1240 x 1240 pixels · wide-field fundus photograph of an infant · Phoenix ICON, 100° FOV.
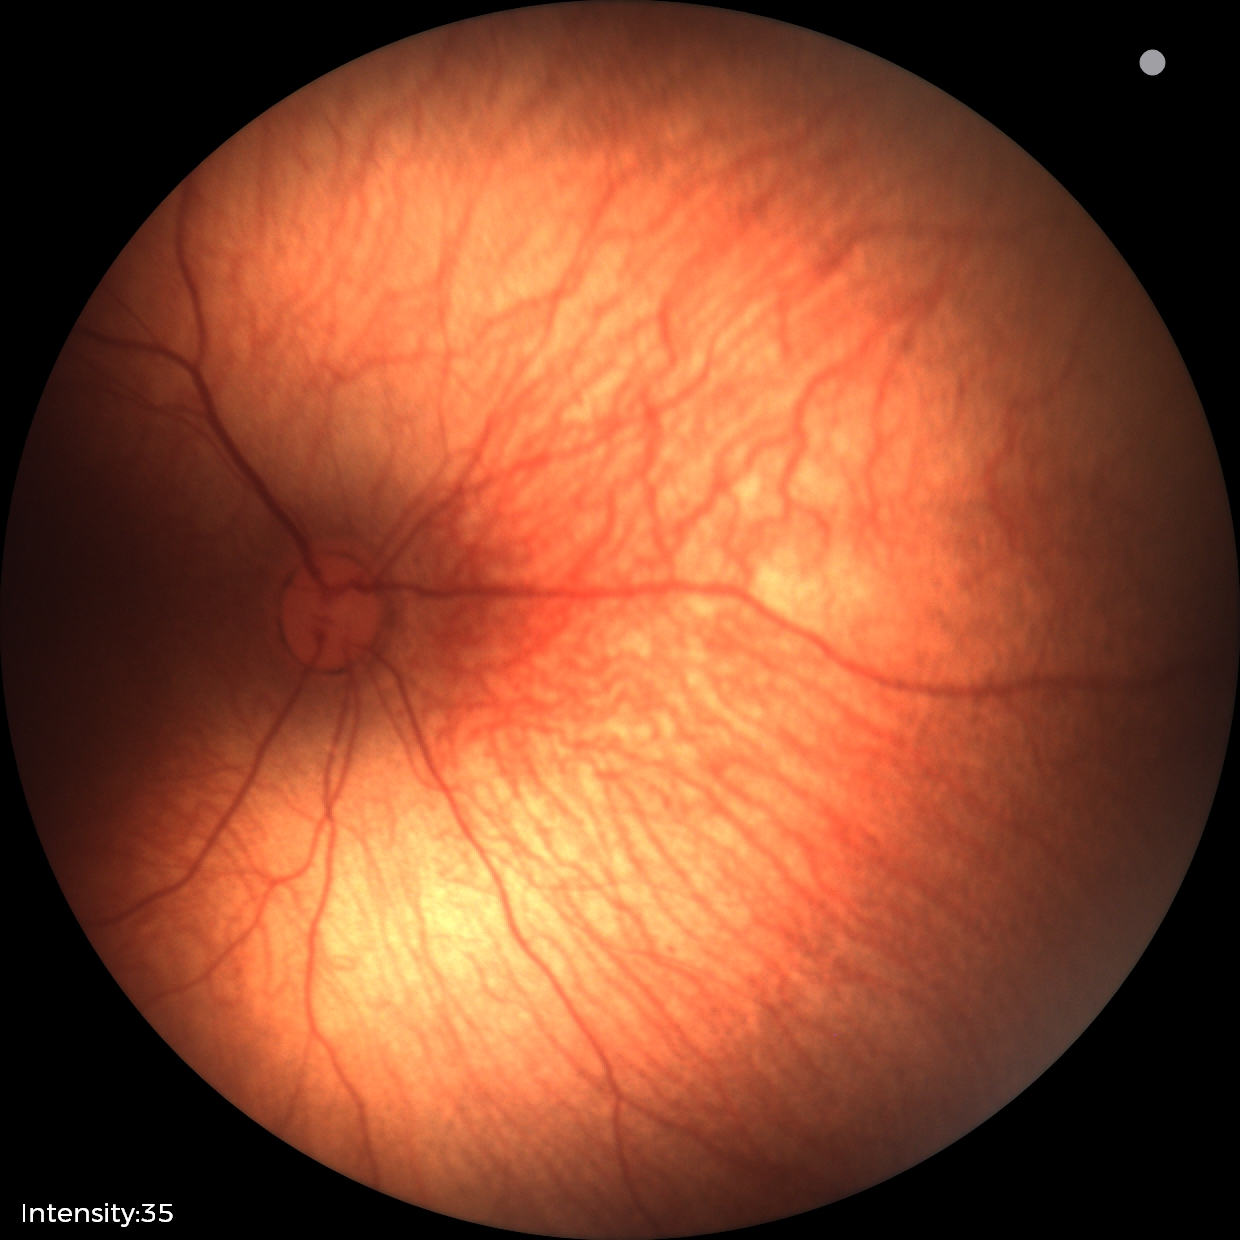
Impression = physiological appearance.